2352x1568px — 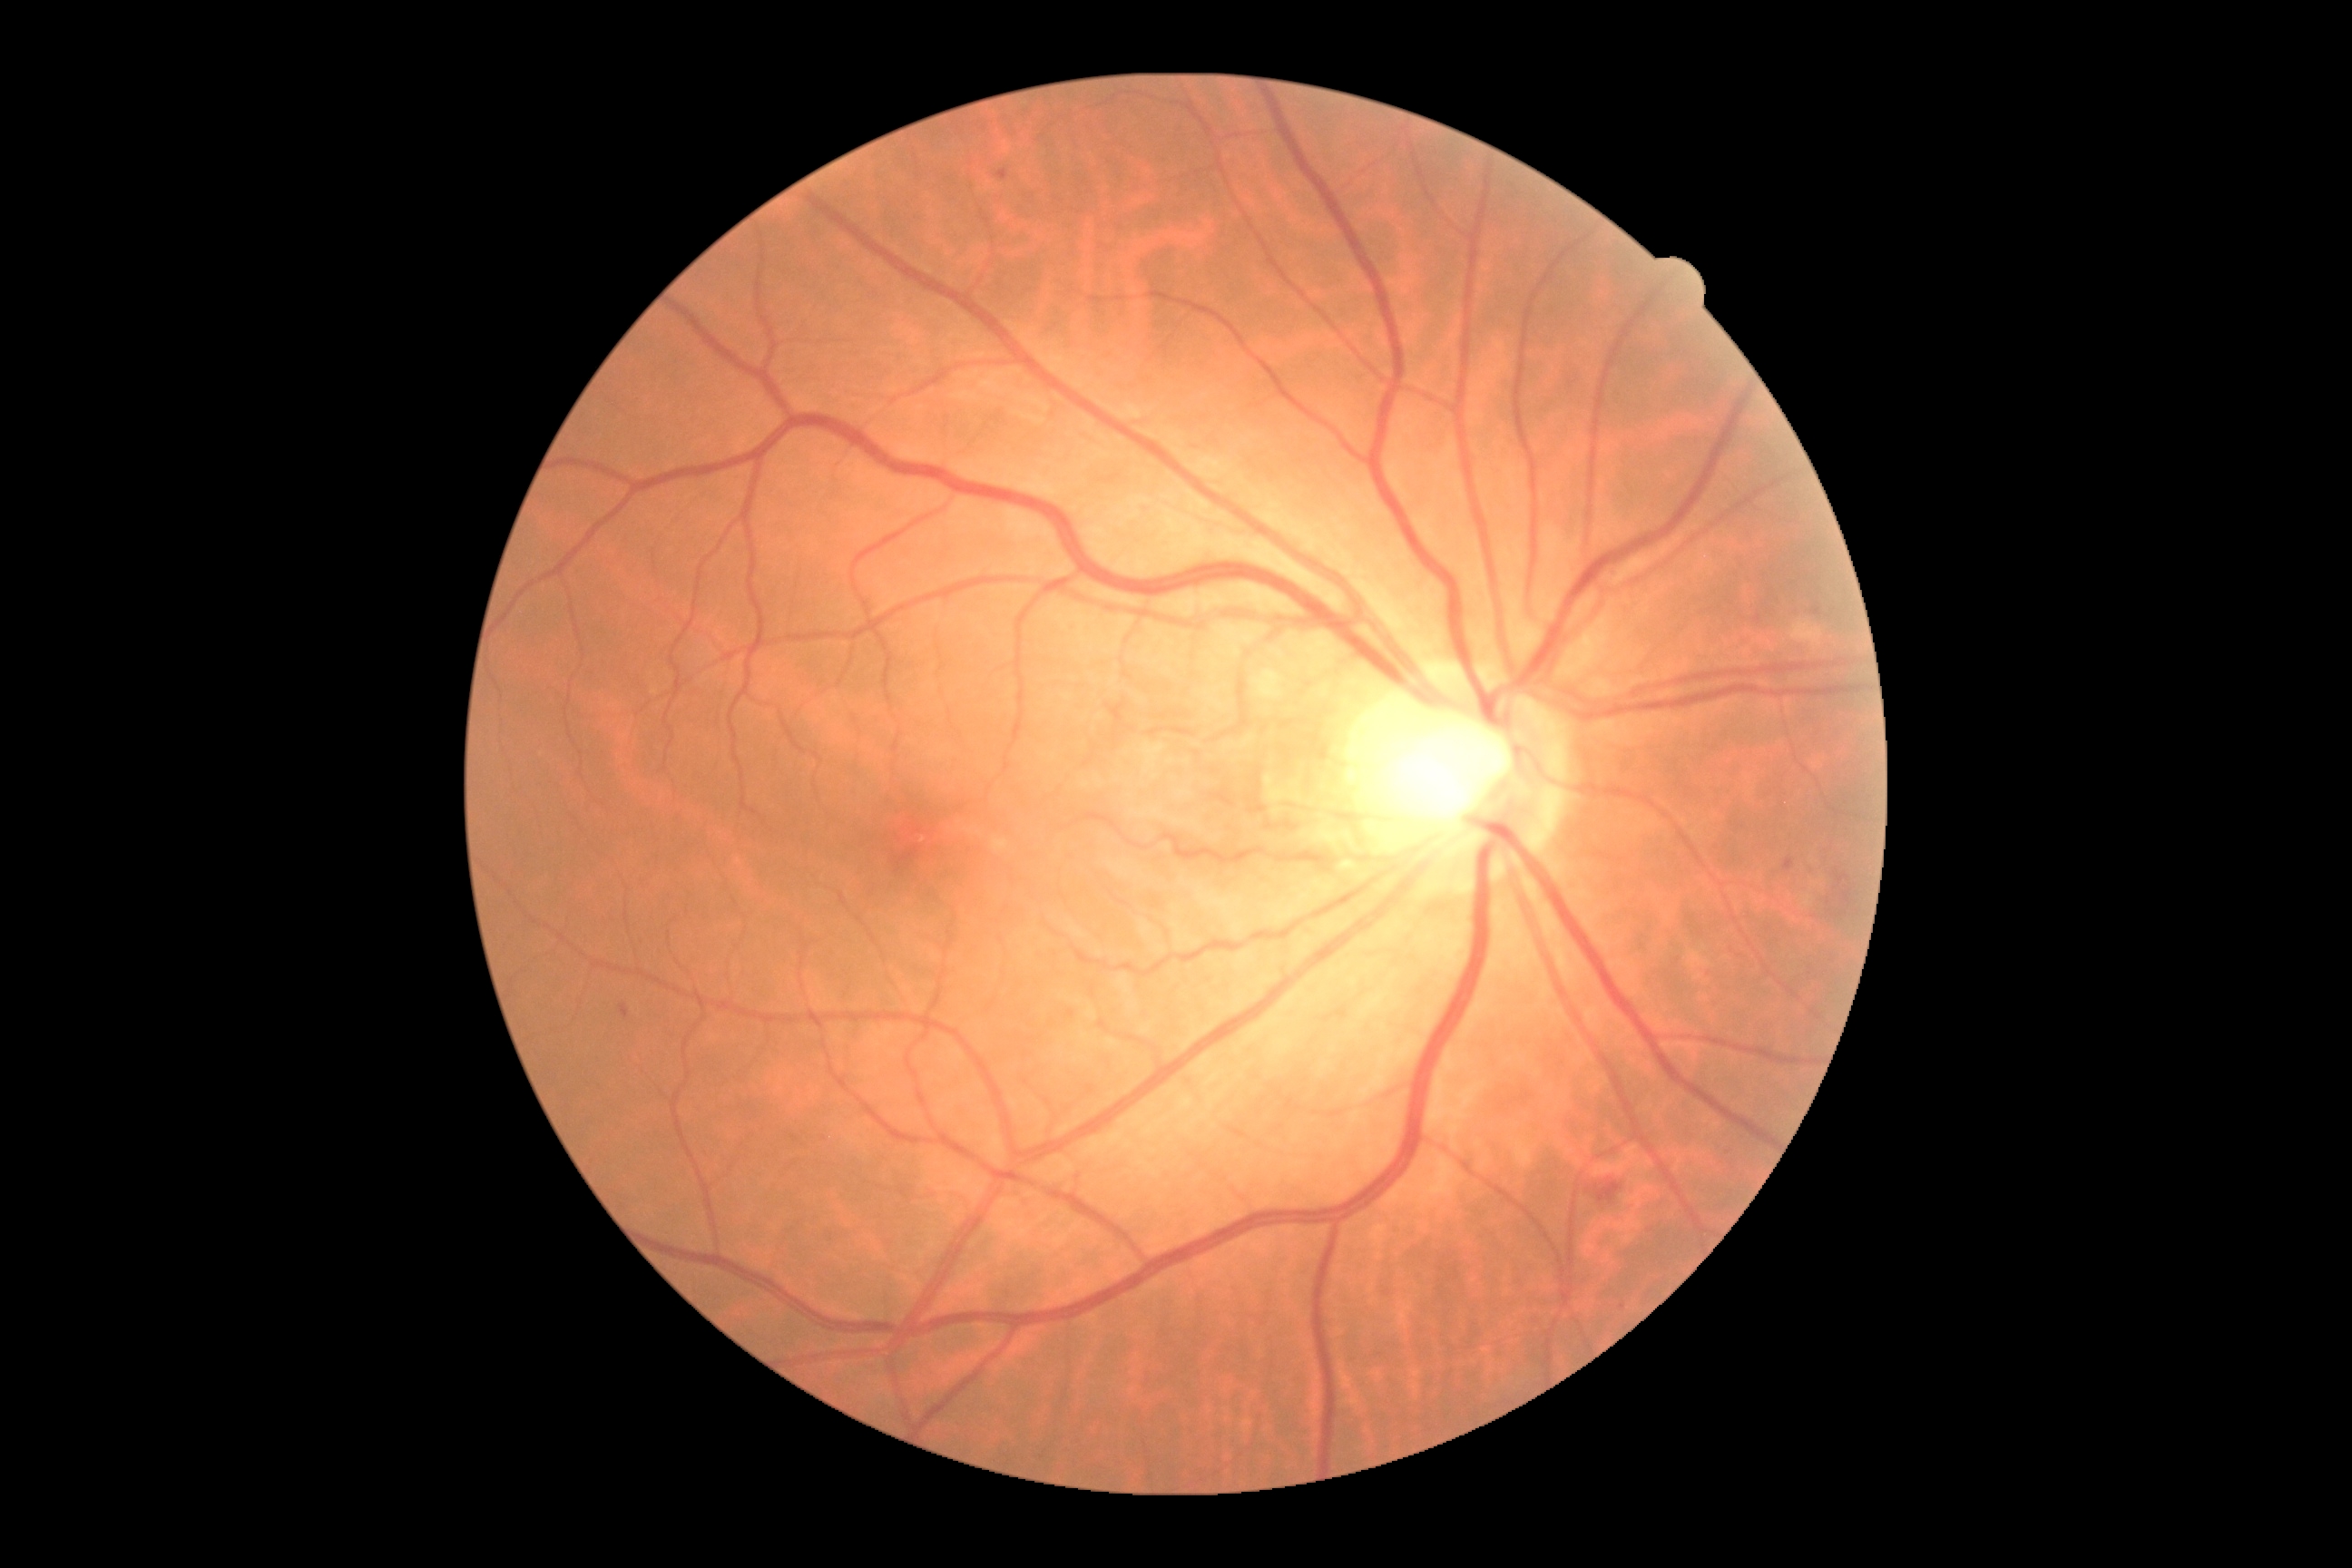 Diabetic retinopathy severity: grade 2 (moderate NPDR).